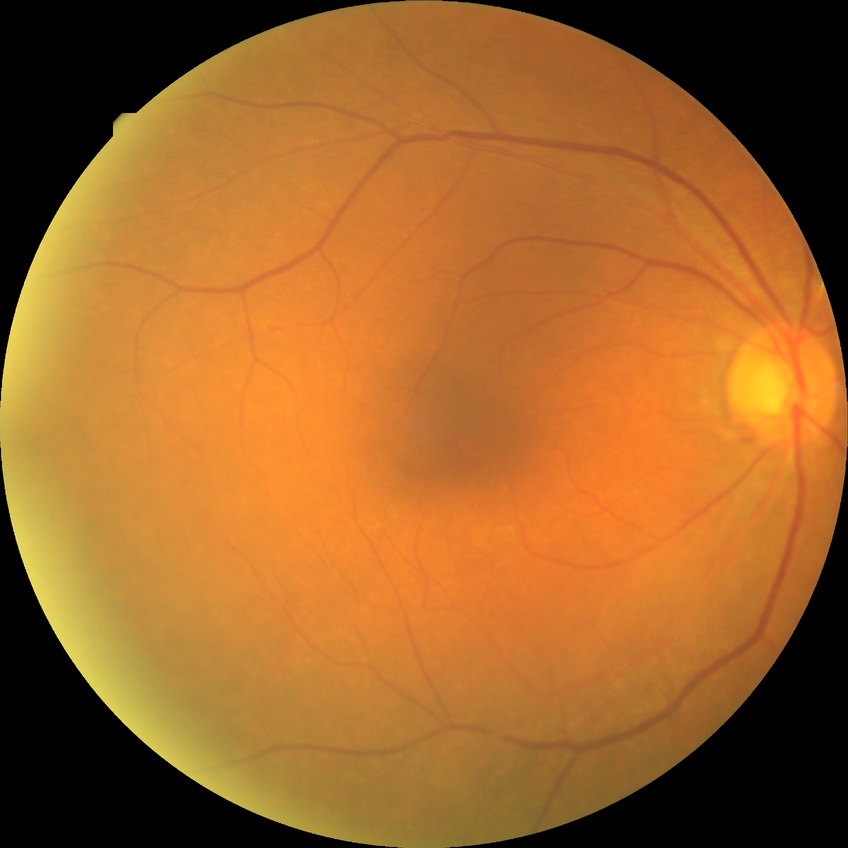

No signs of diabetic retinopathy. Modified Davis grade is NDR.